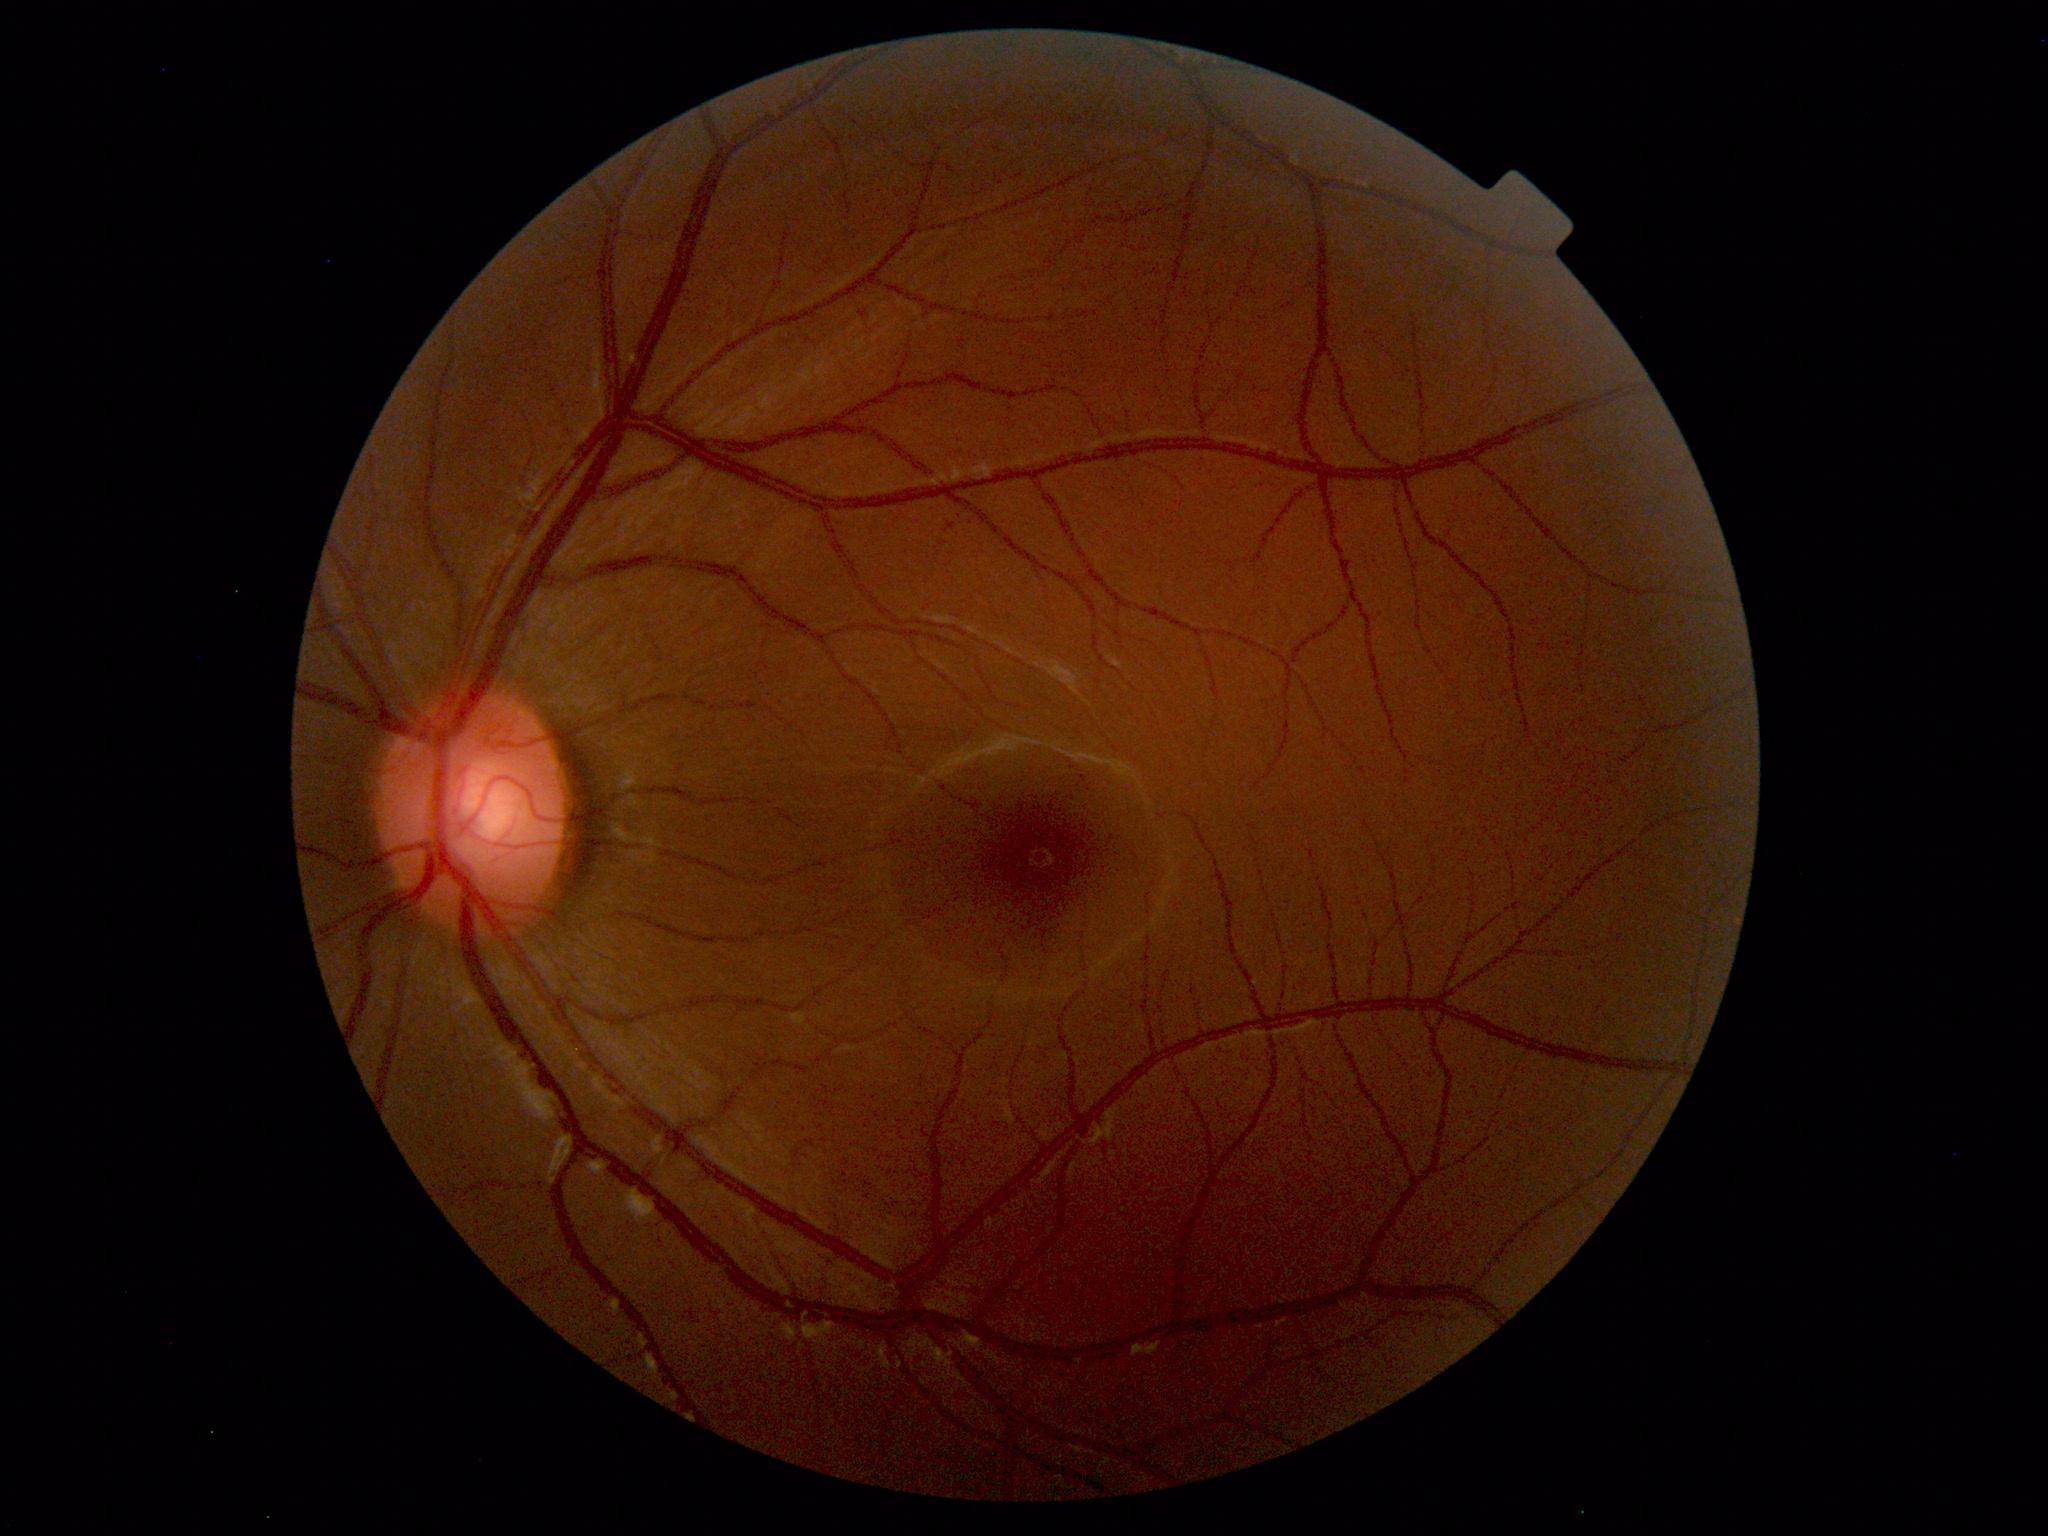

Fundus photograph within normal limits.